FOV: 45 degrees
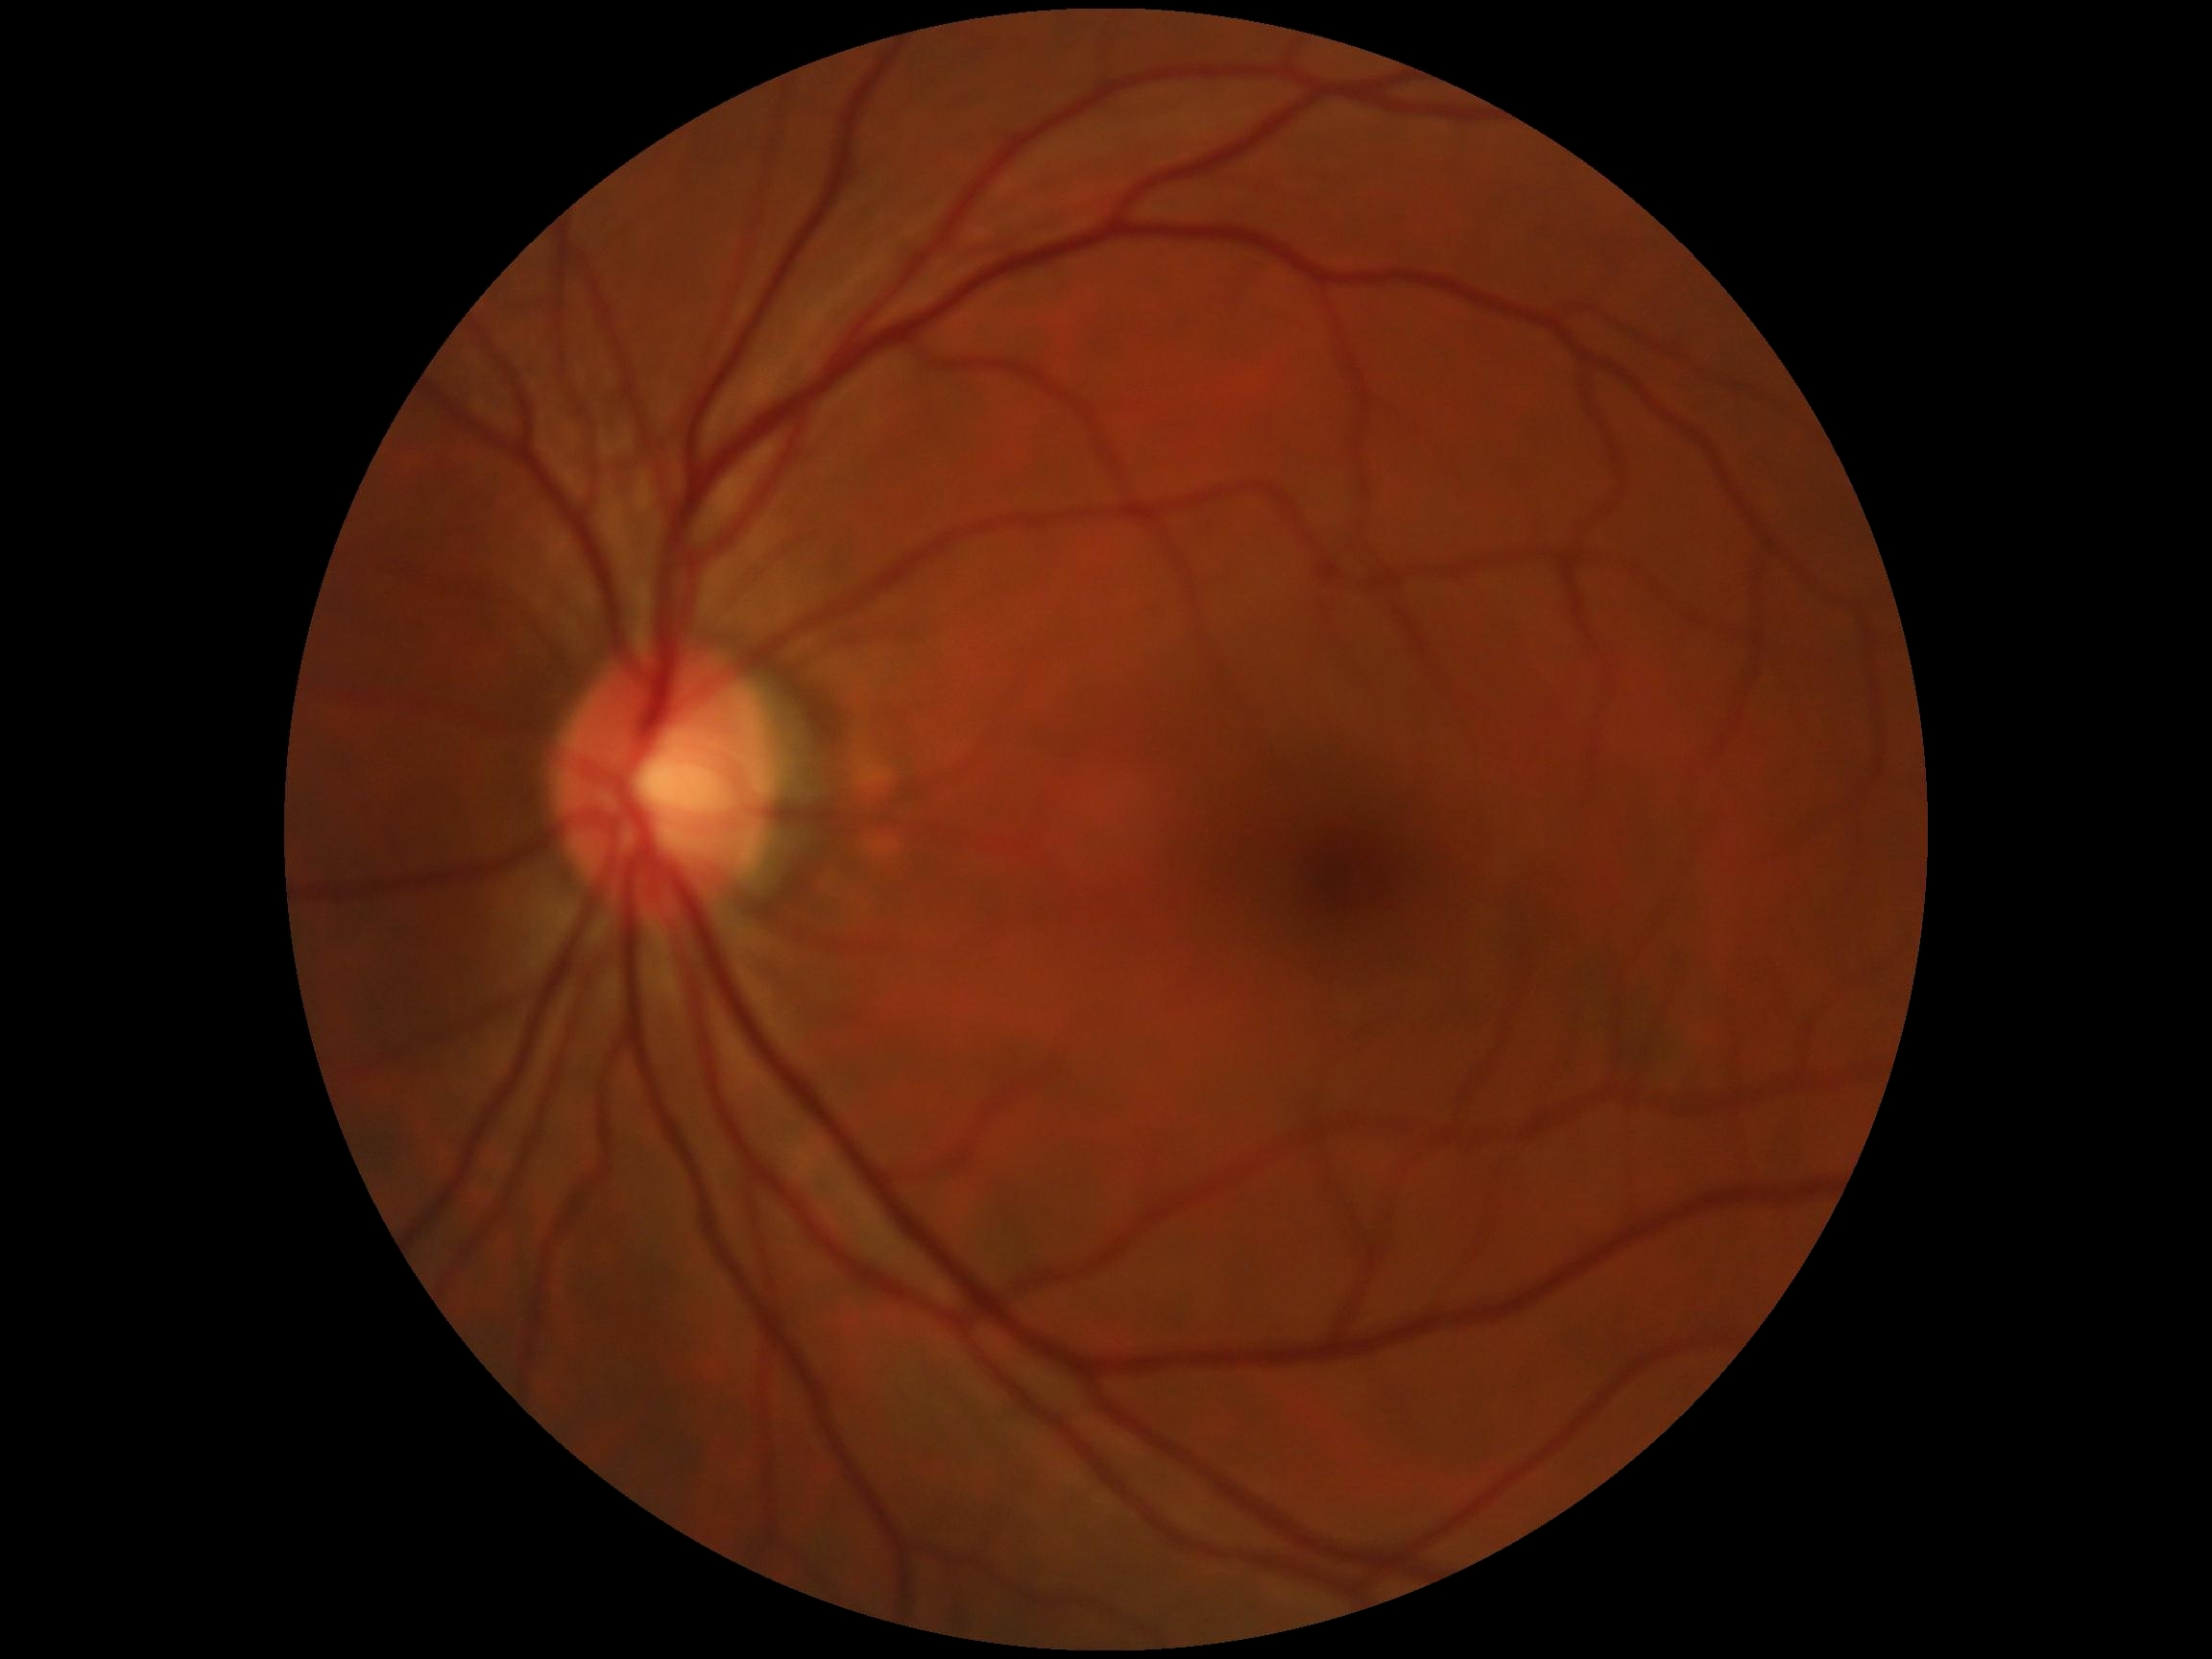

DR grade is 0 (no apparent retinopathy).